1932 x 1916 pixels. CFP
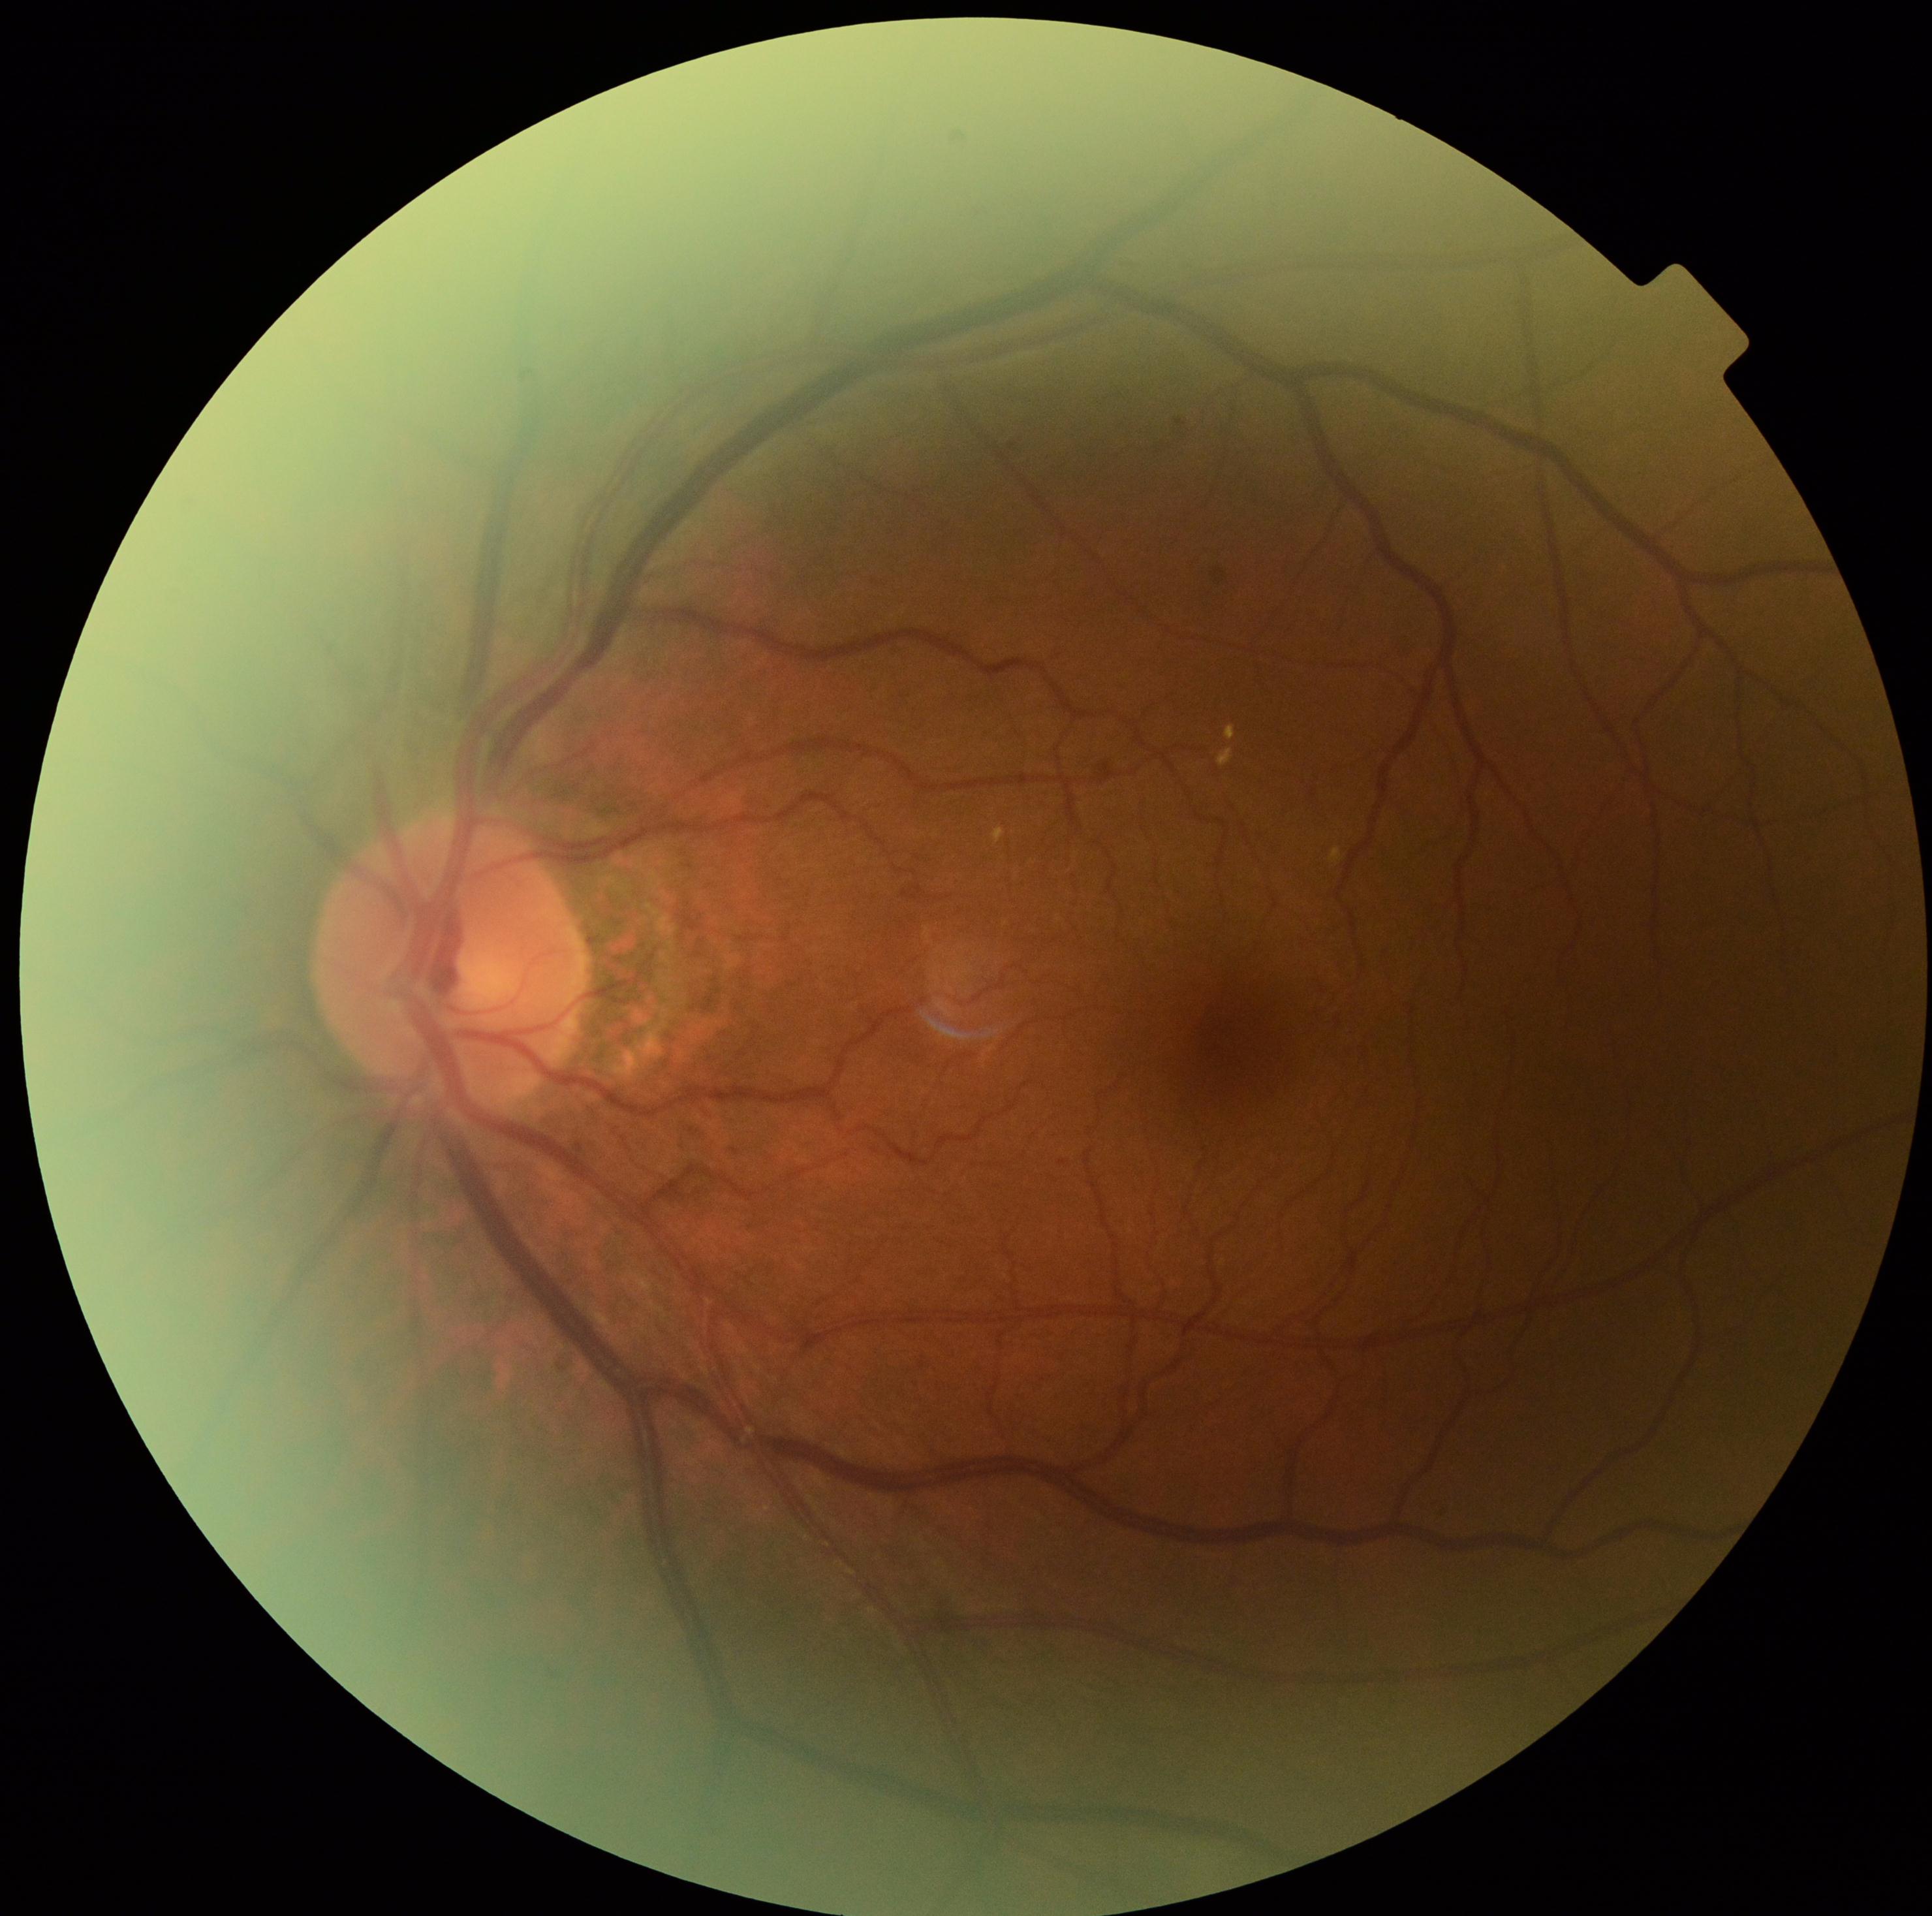

Diabetic retinopathy grade: 2 — more than just microaneurysms but less than severe NPDR. The retinopathy is classified as non-proliferative diabetic retinopathy.